45° FOV:
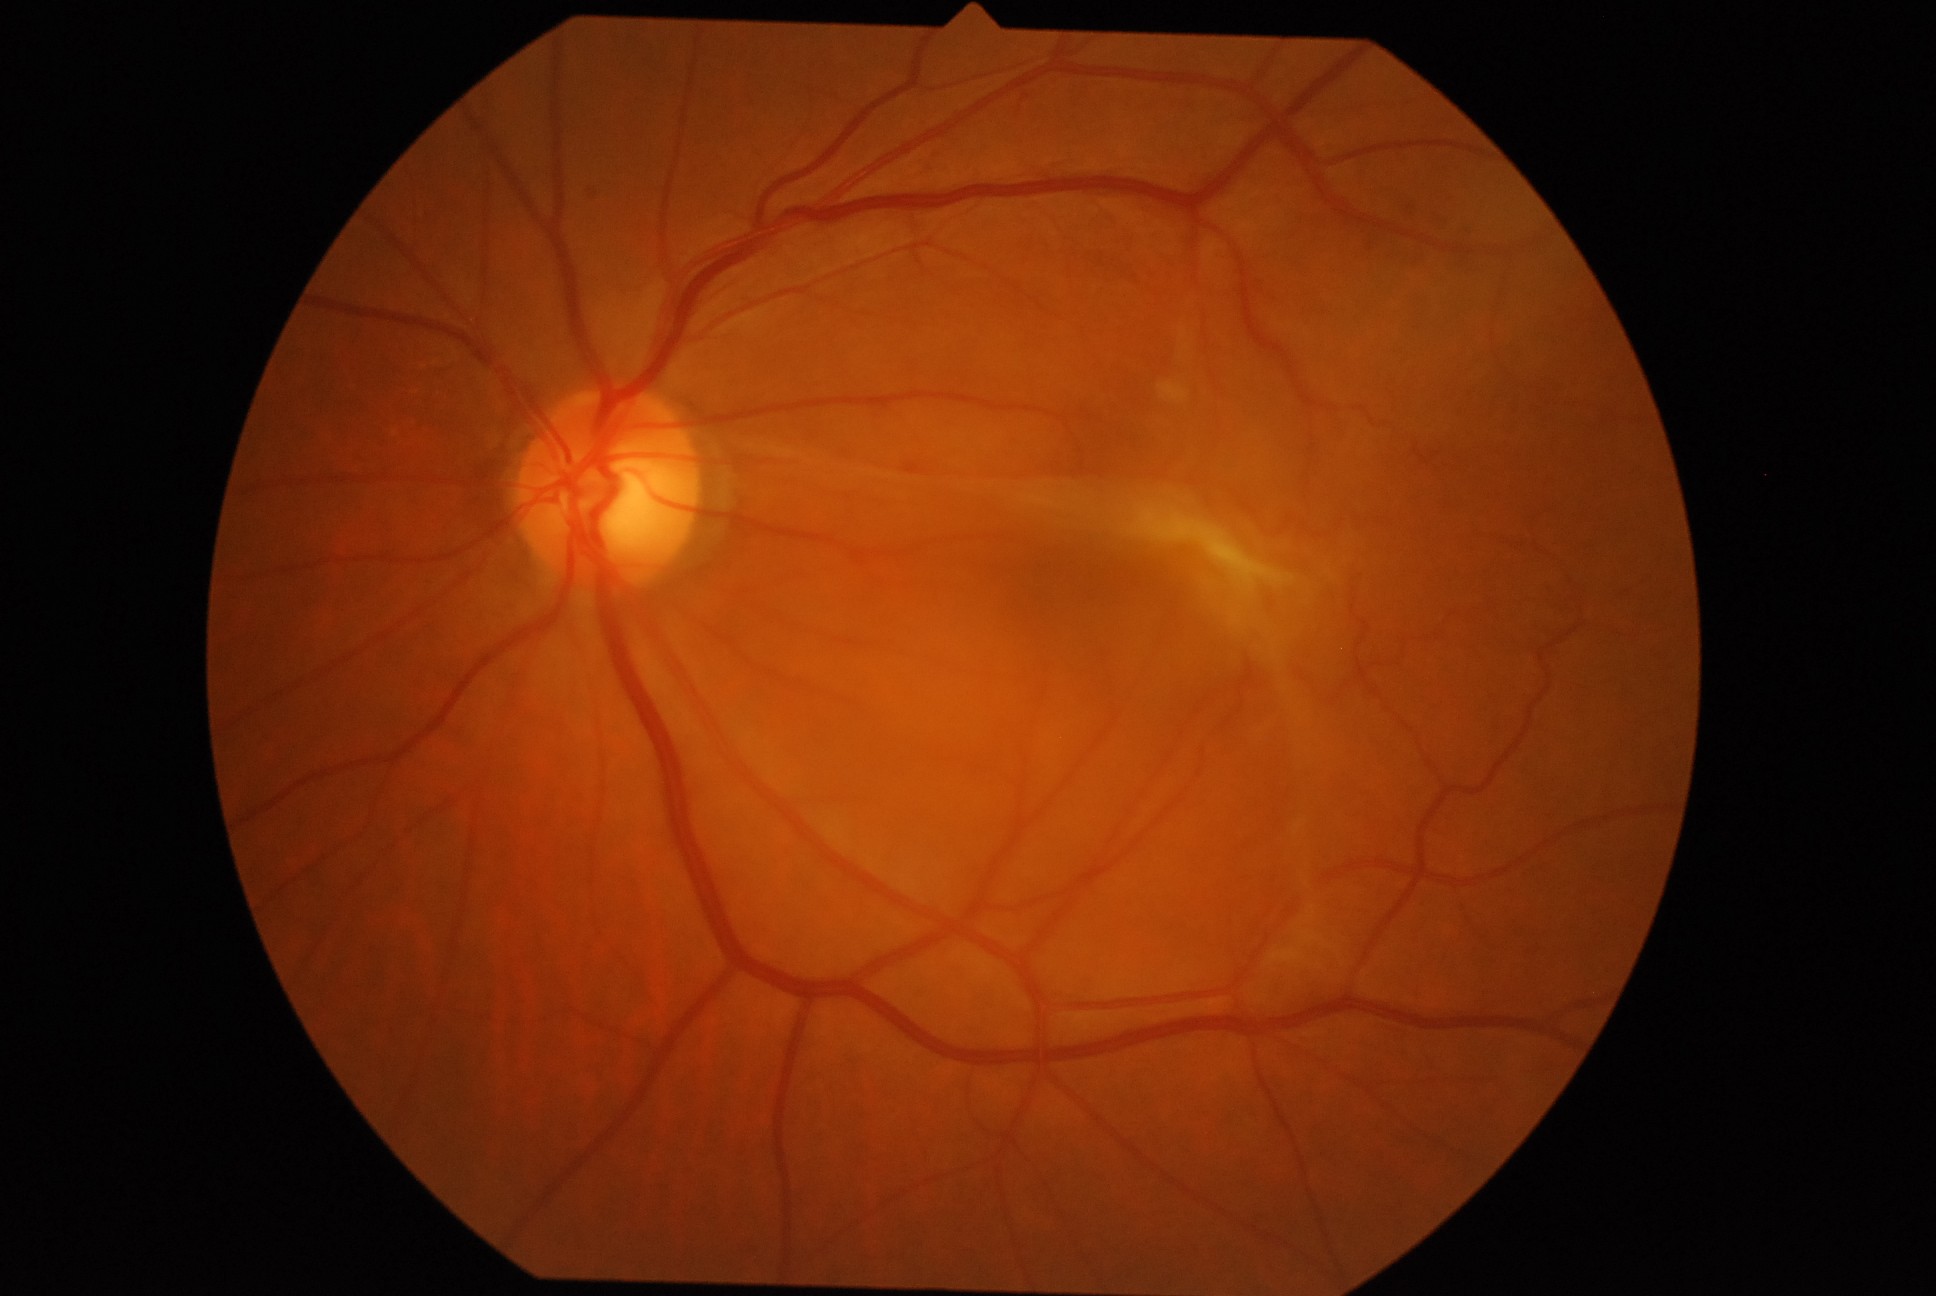
Diabetic retinopathy (DR) is proliferative diabetic retinopathy (grade 4) — neovascularization and/or vitreous/pre-retinal hemorrhage.